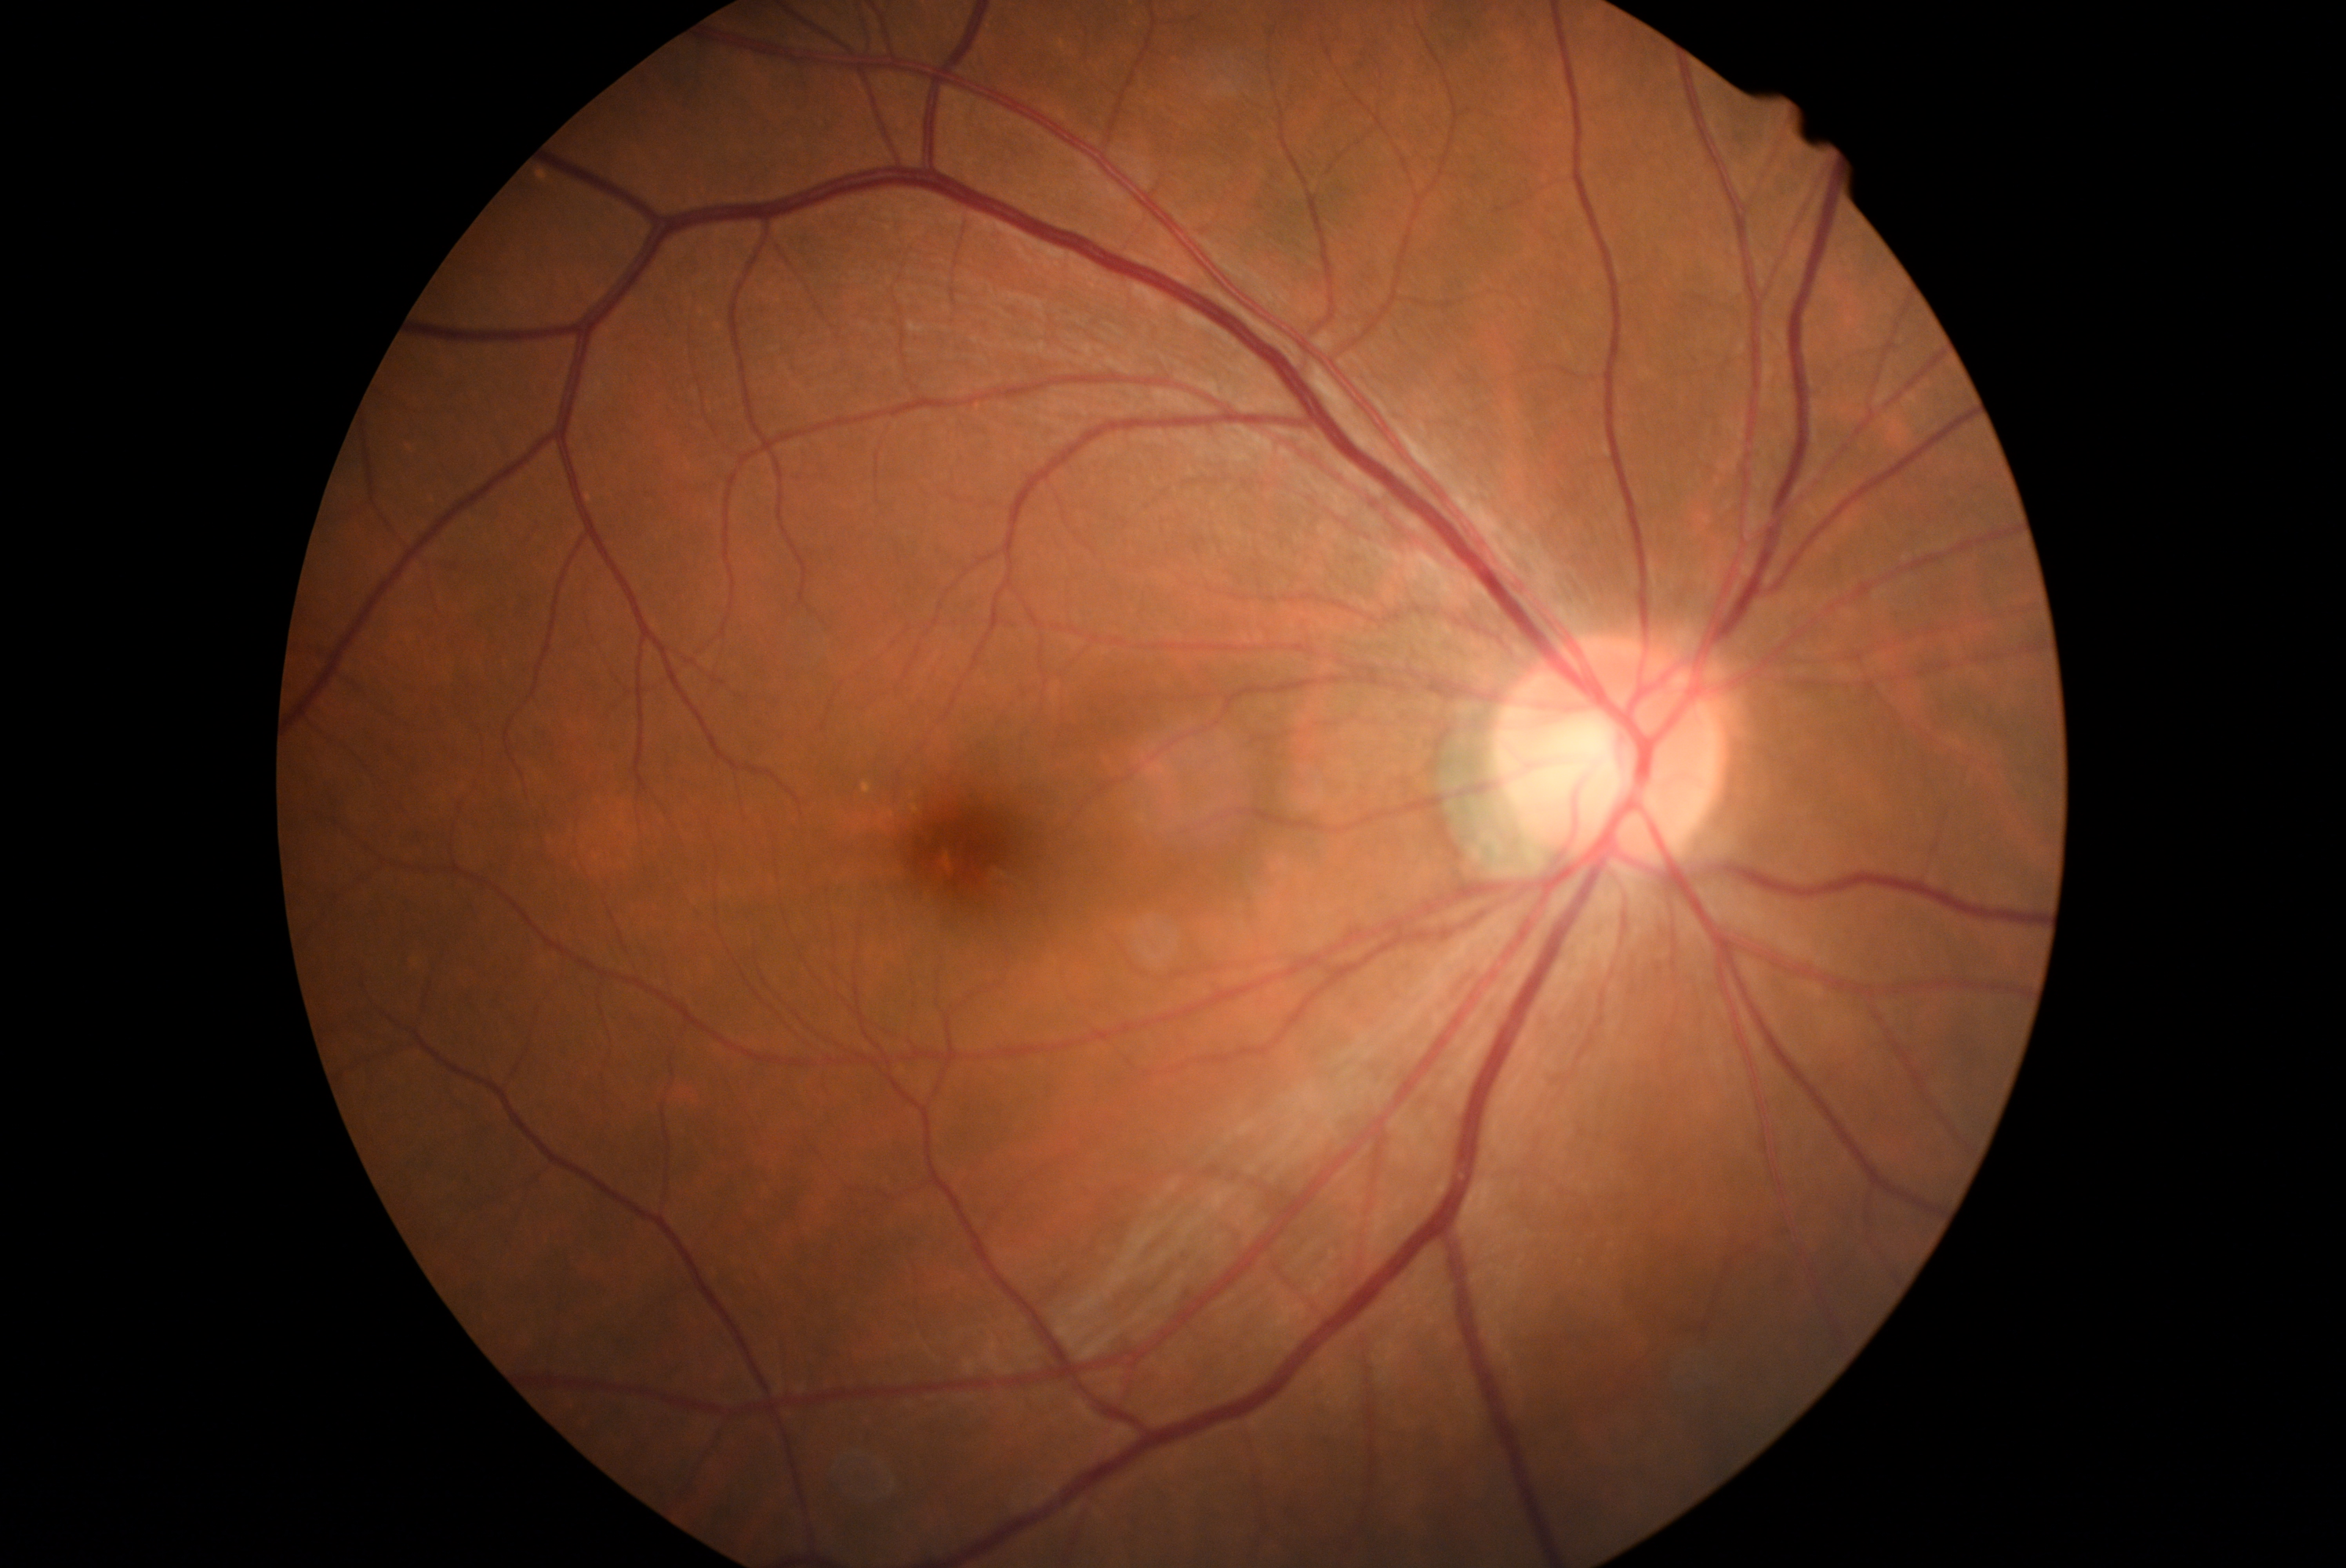 Diabetic retinopathy (DR): grade 0. No DR findings.